Nonmydriatic; 45° FOV; 848 x 848 pixels; acquired with a NIDEK AFC-230; posterior pole photograph — 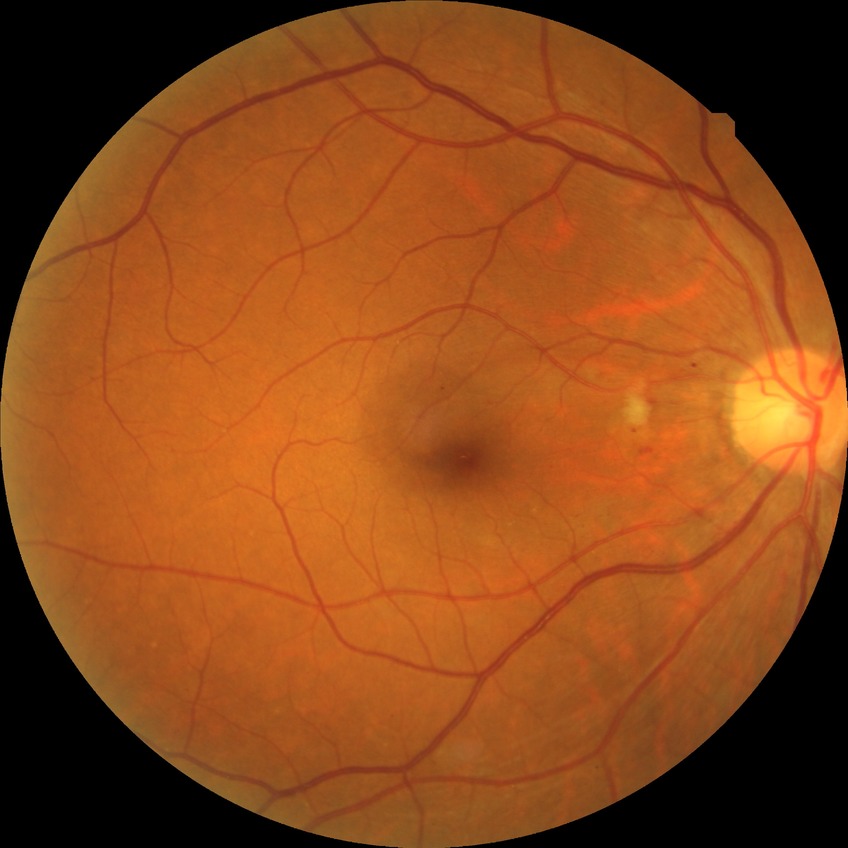 Annotations:
• diabetic retinopathy (DR) — SDR (simple diabetic retinopathy)